CFP — 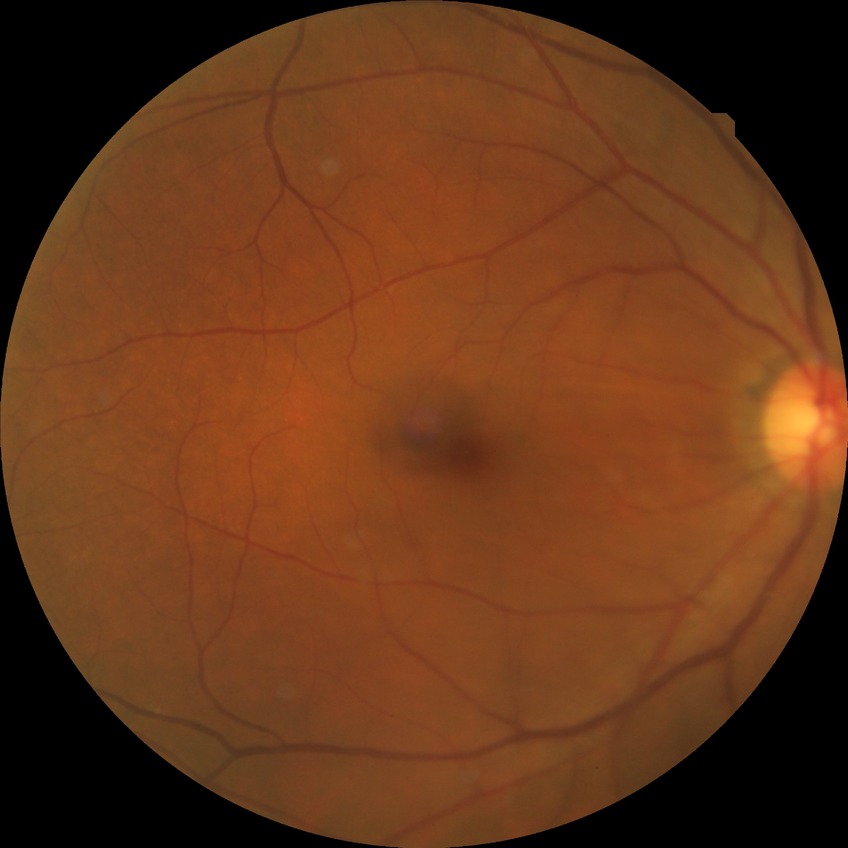
Diabetic retinopathy (DR): NDR (no diabetic retinopathy).